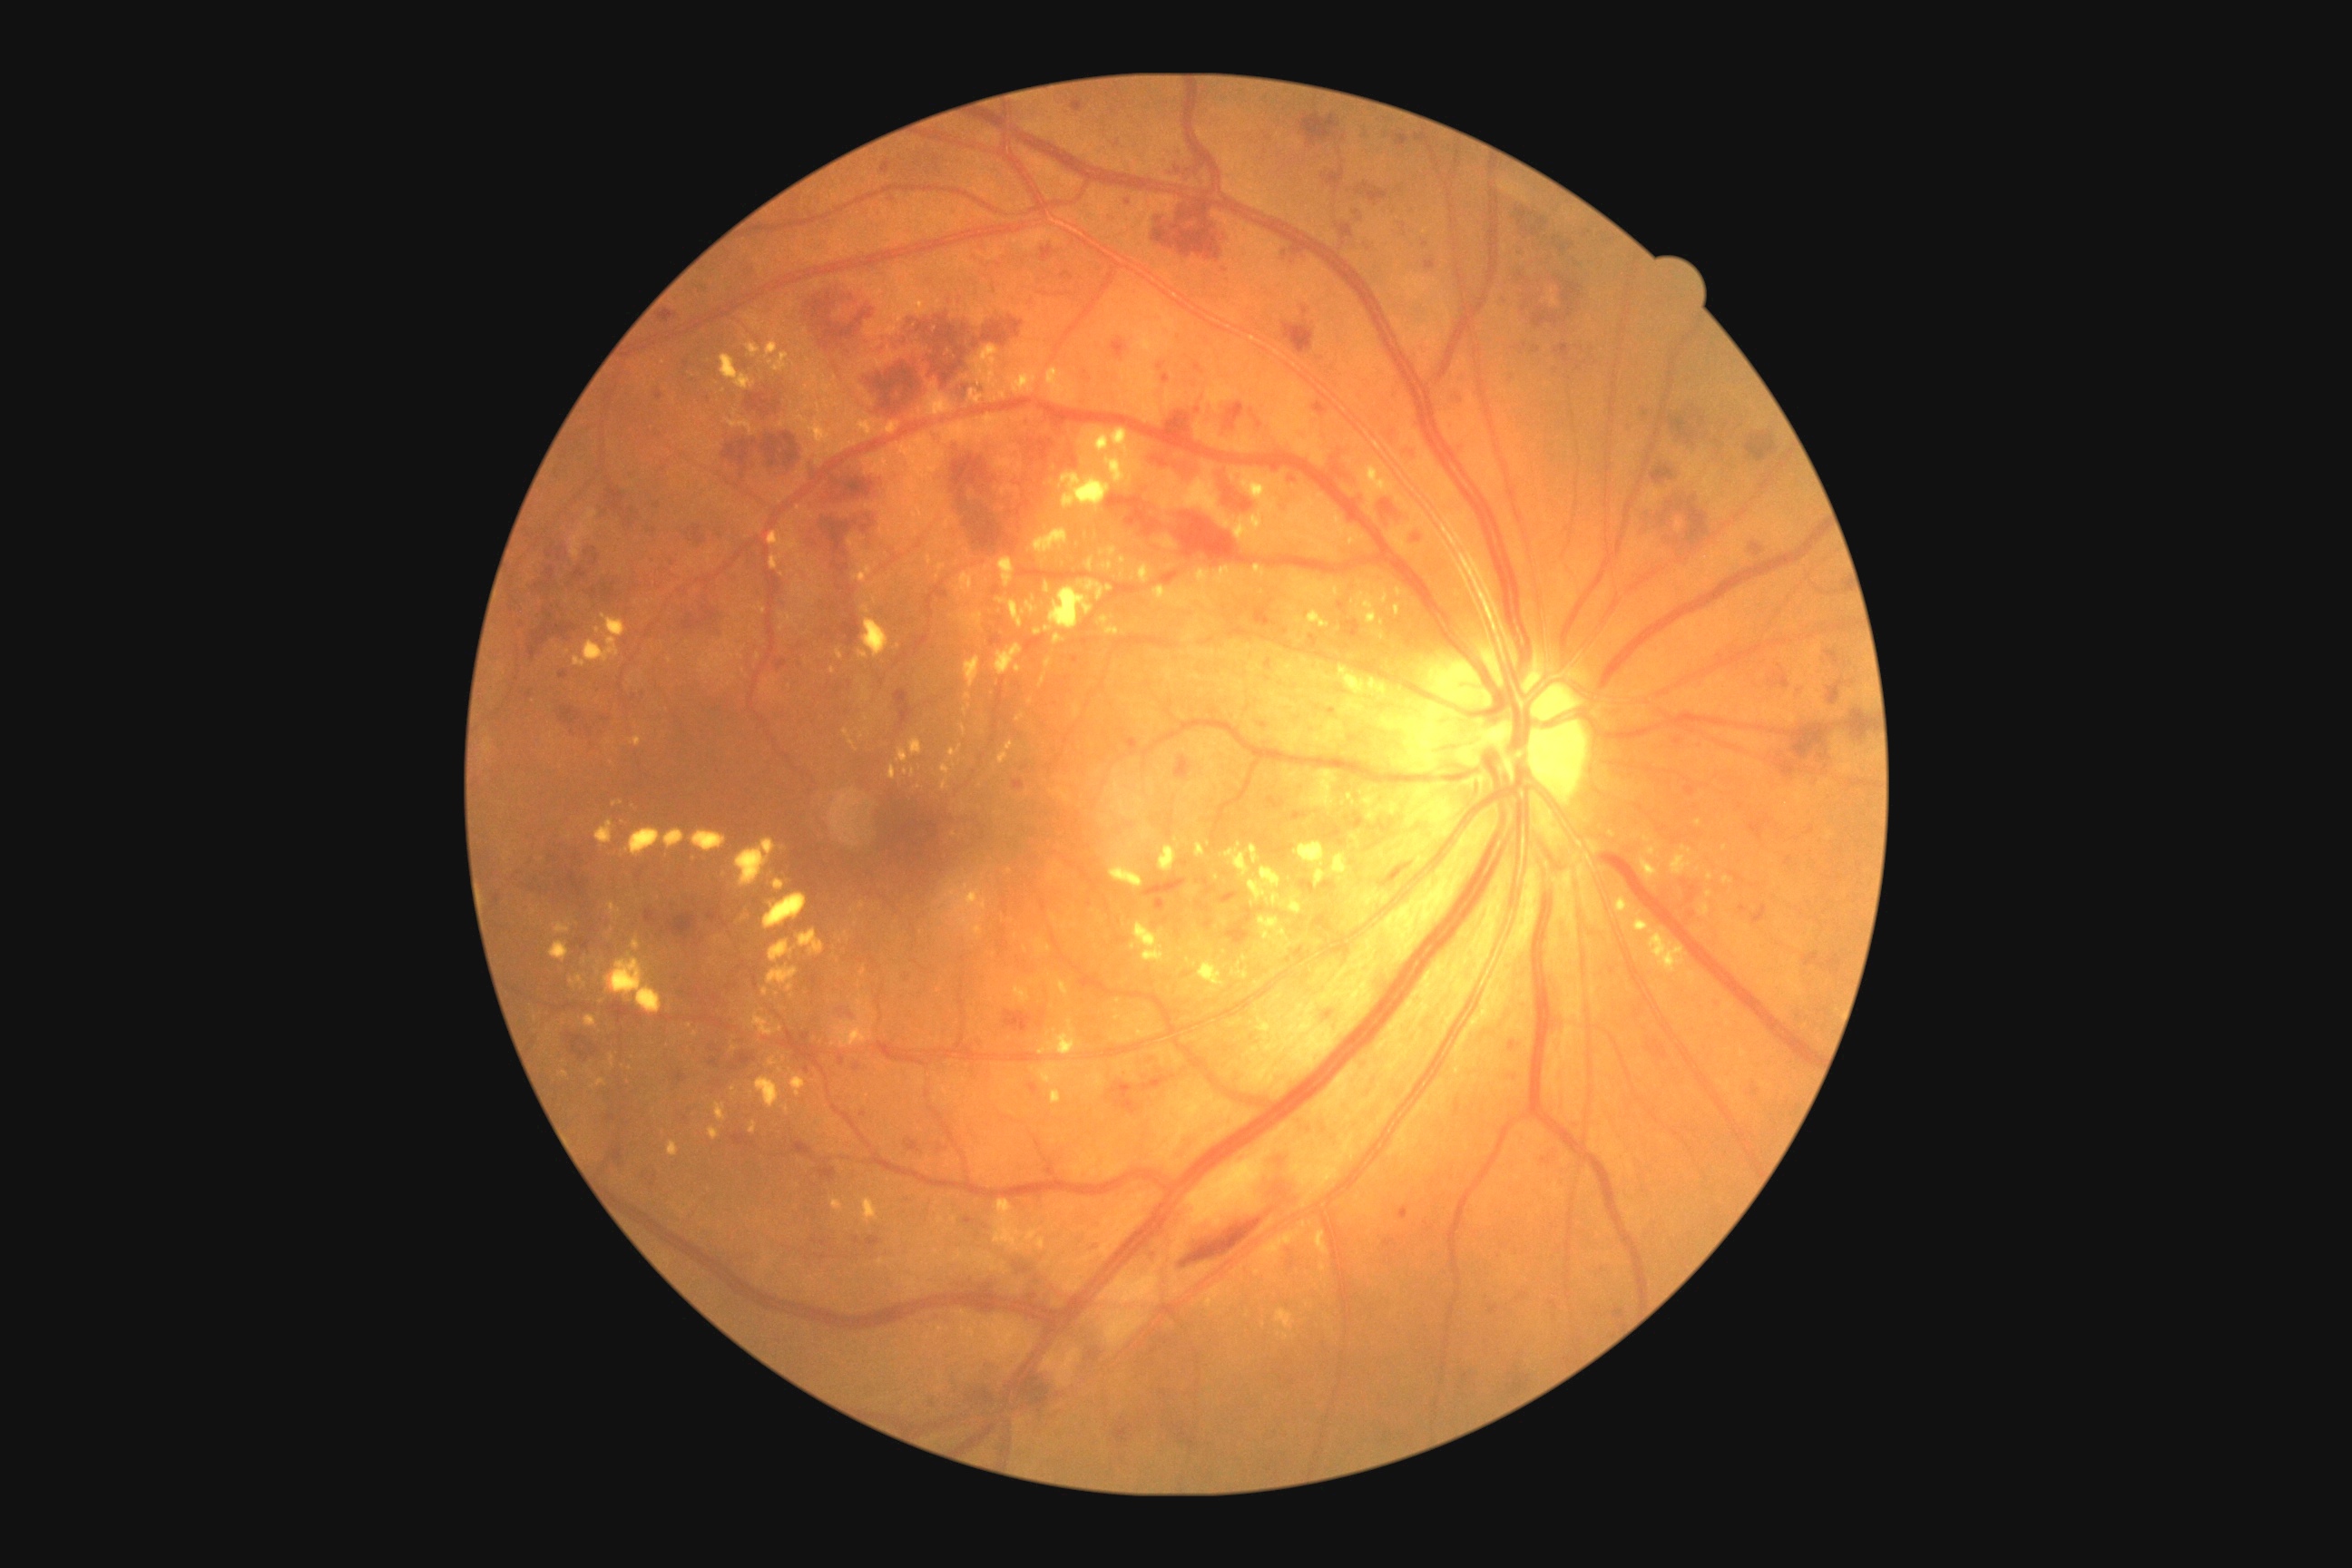 Diabetic retinopathy: 3/4
Selected lesions:
hard exudates (more not shown): left=1035, top=939, right=1052, bottom=956; left=1039, top=672, right=1048, bottom=687; left=861, top=605, right=870, bottom=614; left=932, top=299, right=941, bottom=309; left=607, top=903, right=622, bottom=916; left=1122, top=698, right=1130, bottom=703; left=761, top=988, right=769, bottom=997; left=1222, top=843, right=1248, bottom=879; left=763, top=894, right=807, bottom=930; left=1291, top=843, right=1333, bottom=861; left=1277, top=1309, right=1295, bottom=1329; left=1139, top=333, right=1162, bottom=353; left=994, top=1200, right=1039, bottom=1253; left=832, top=1199, right=843, bottom=1213
Small hard exudates approximately at x=862, y=905; x=549, y=1031; x=1298, y=619; x=752, y=1093; x=906, y=772